45-degree field of view, 848 x 848 pixels — 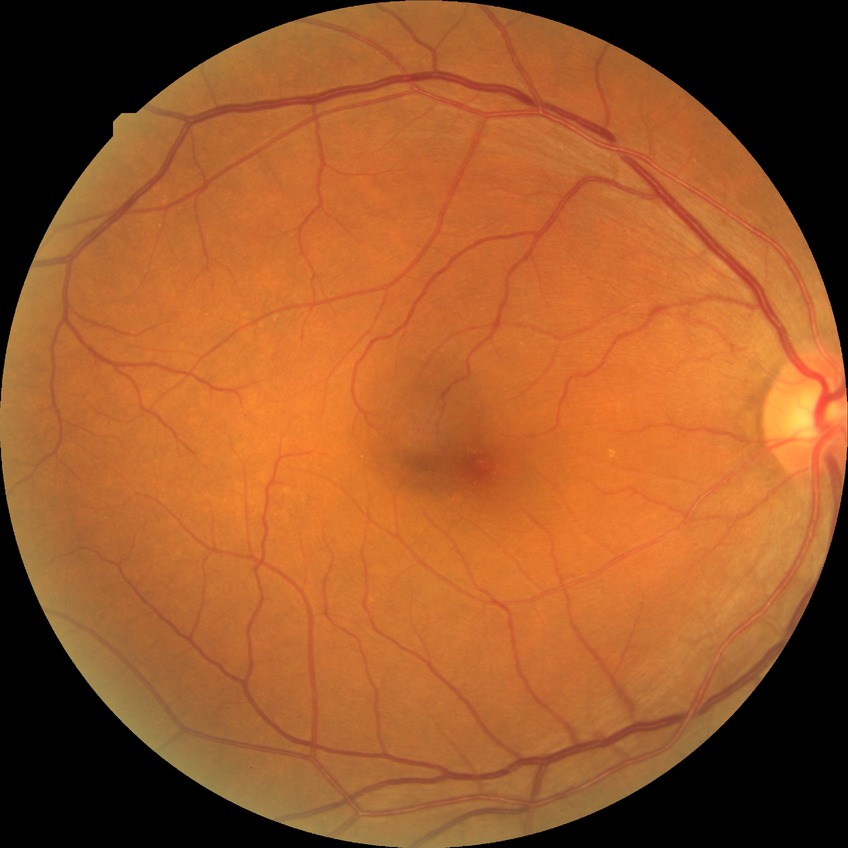

{
  "davis_grade": "no diabetic retinopathy (NDR)"
}